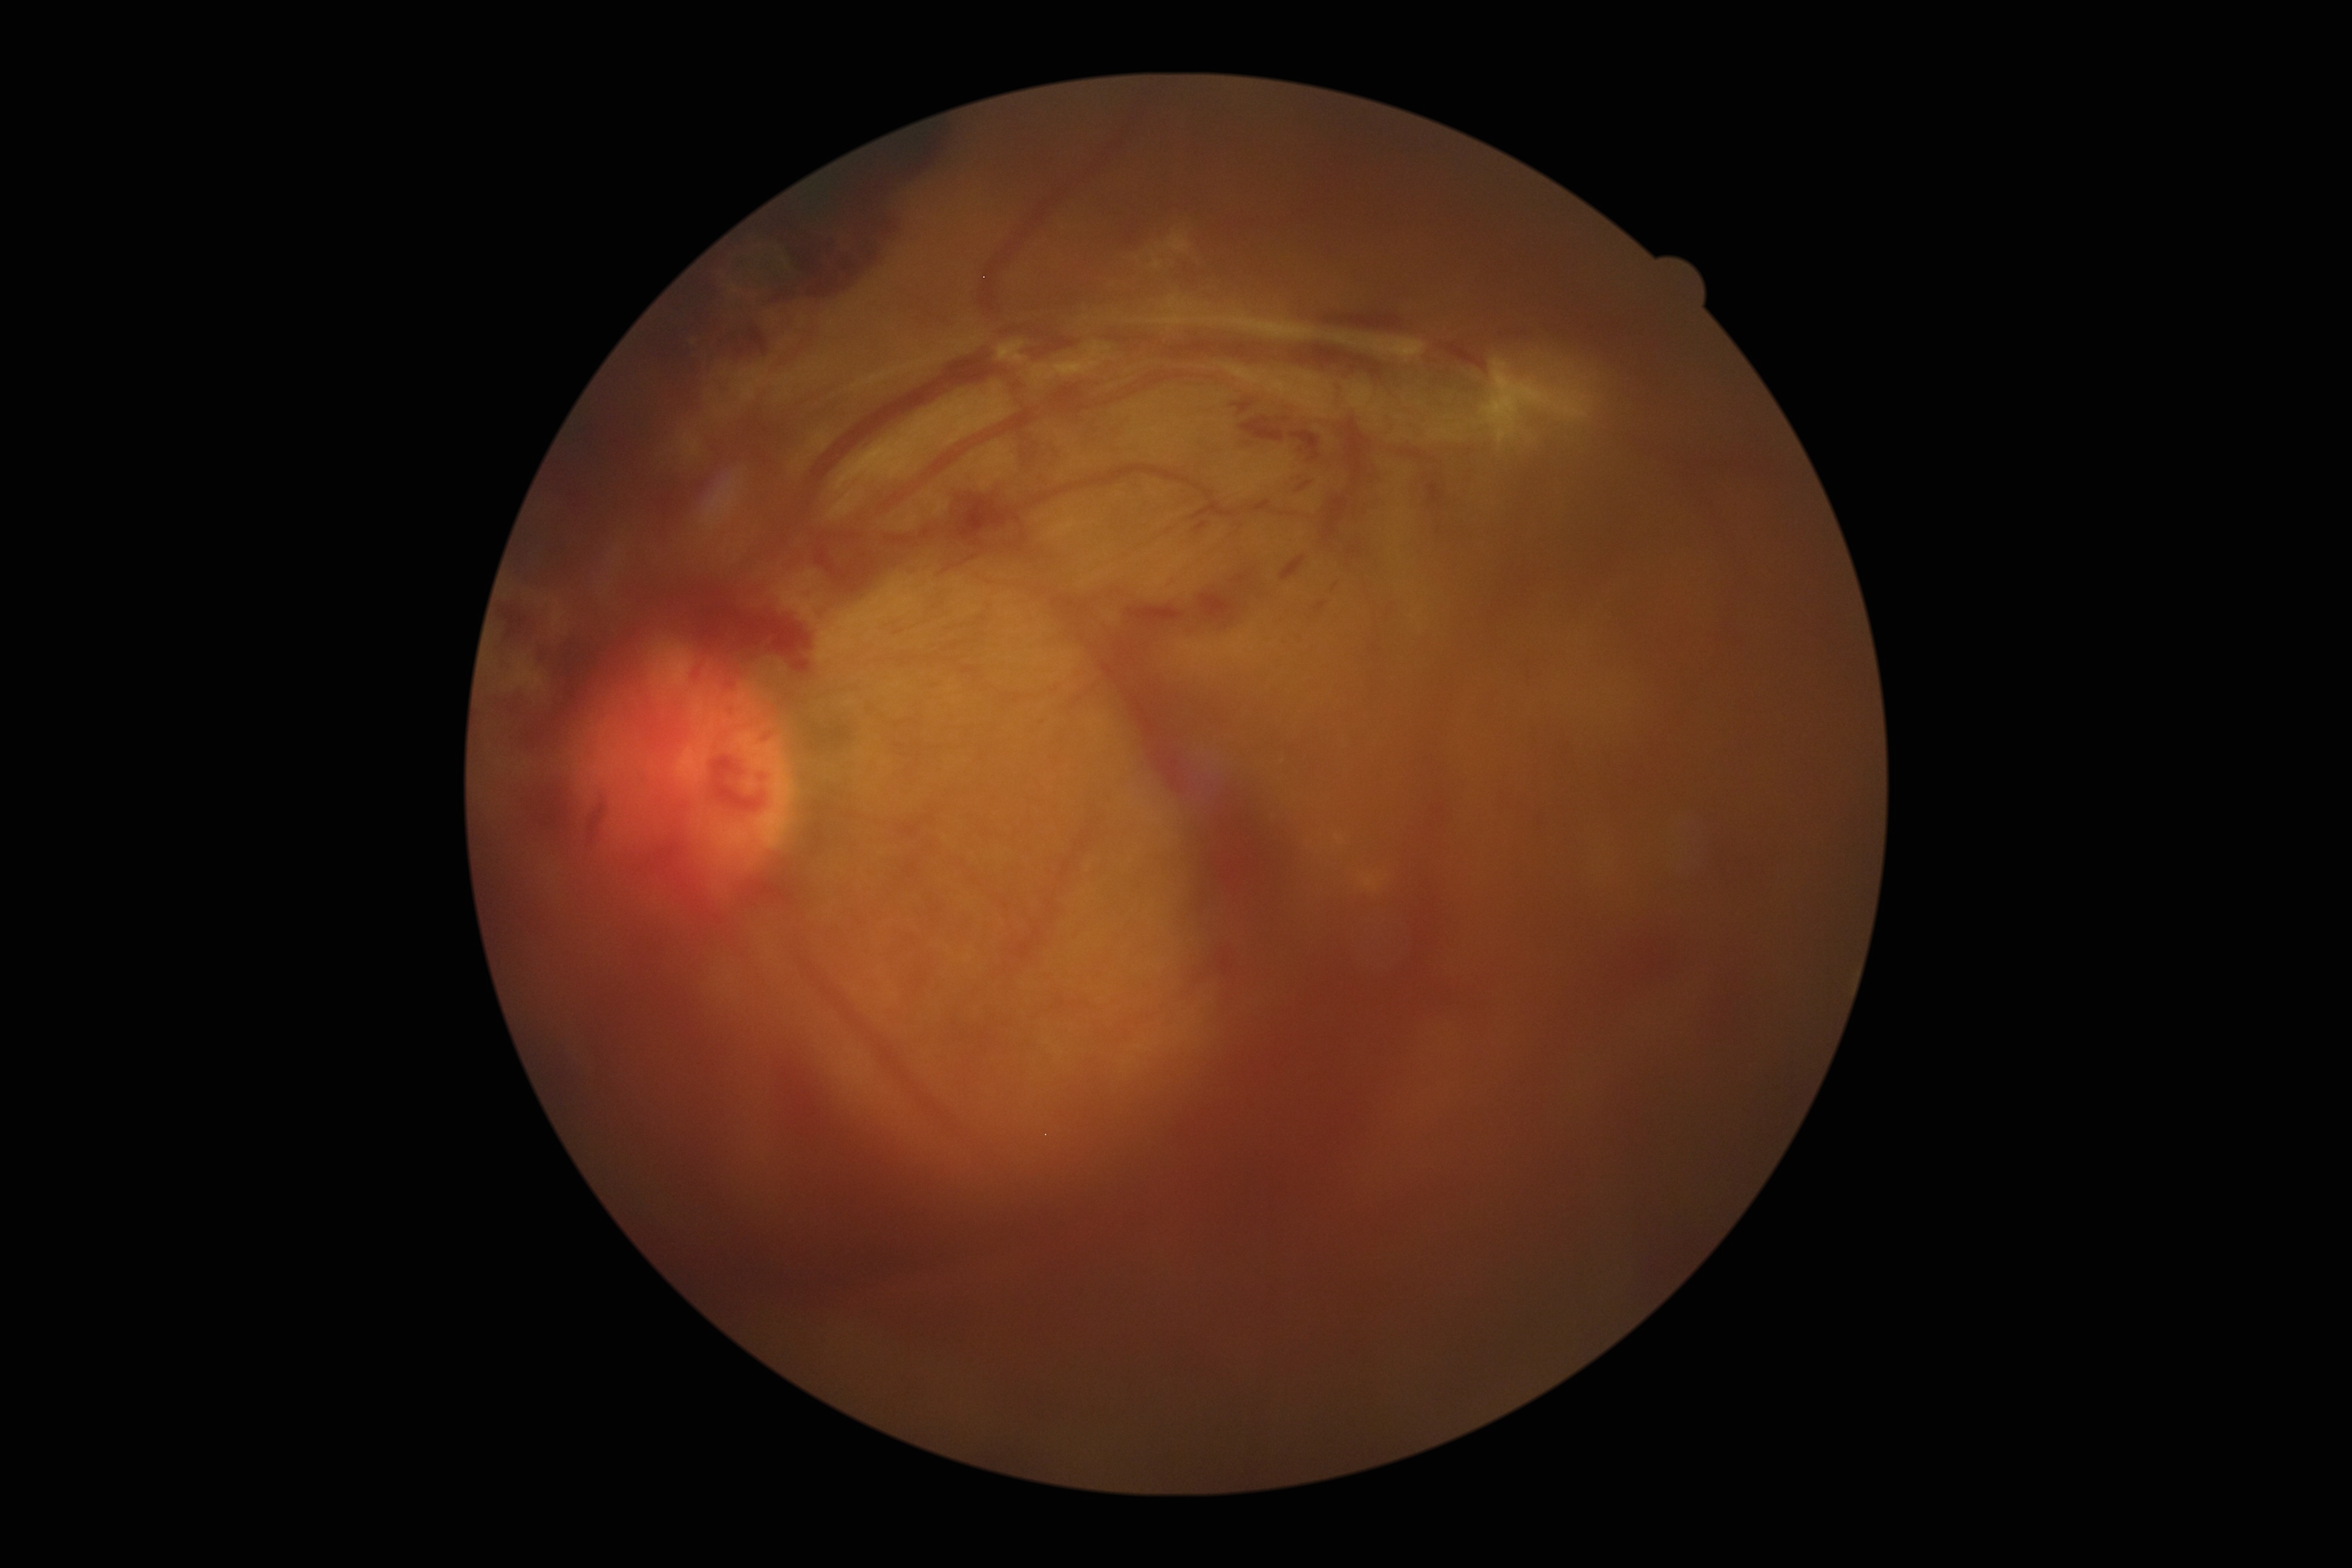 Diabetic retinopathy (DR): 4.